Phoenix ICON wide-field infant fundus image; 1240 by 1240 pixels; 100° field of view (Phoenix ICON):
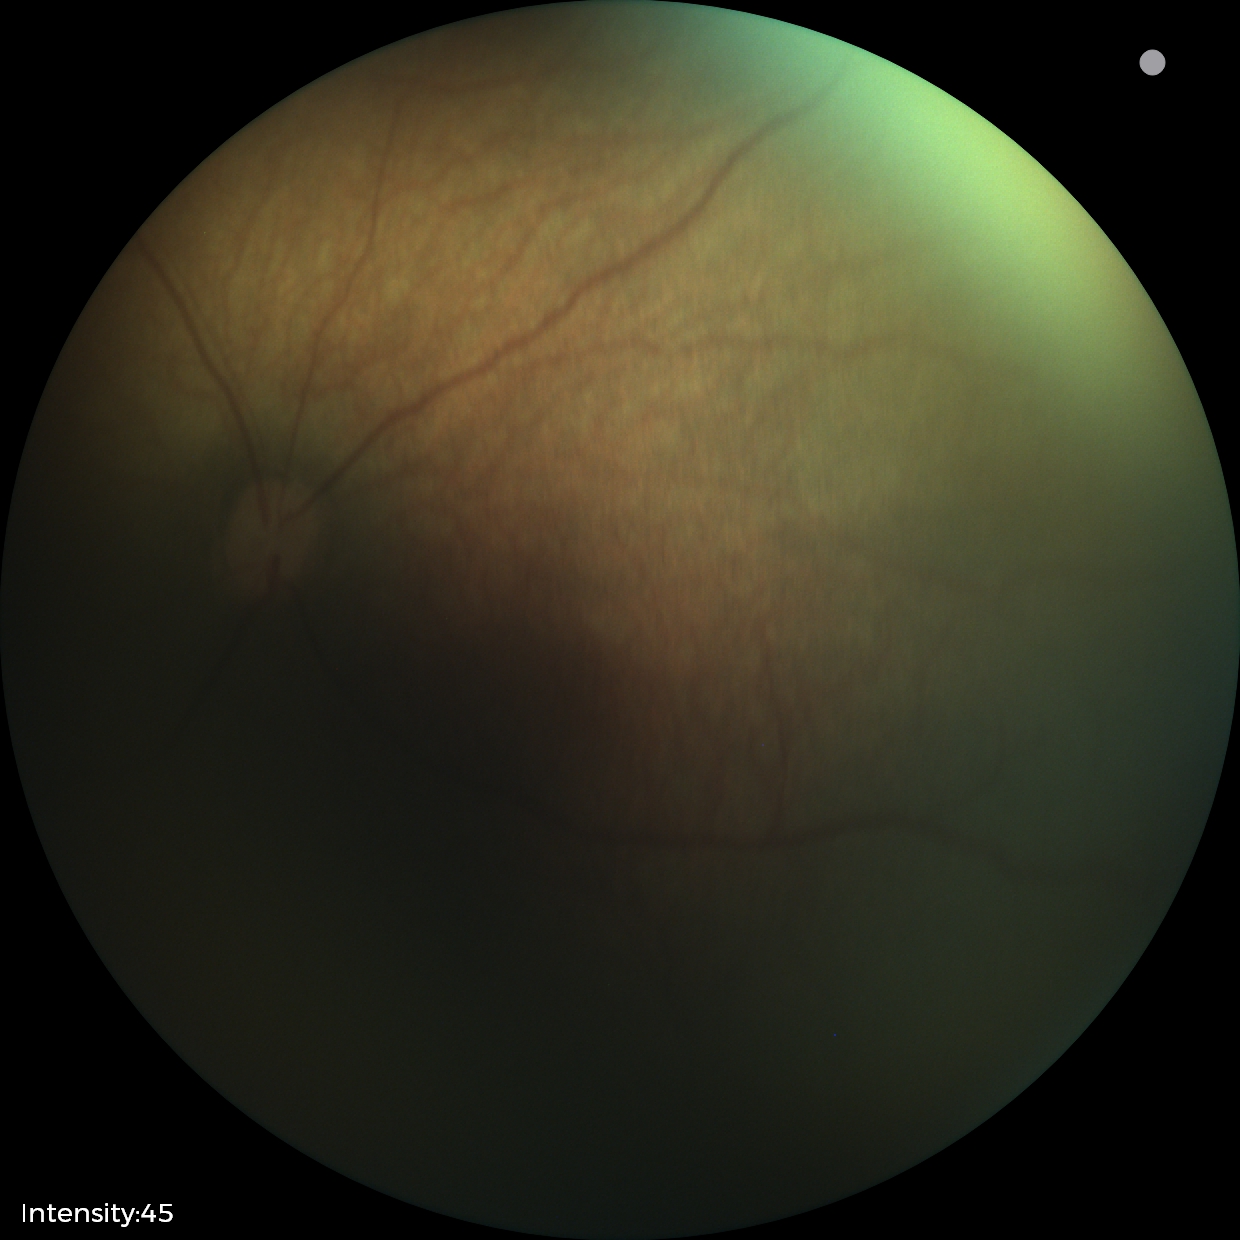 Screening examination with no abnormal retinal findings.